Image size 2048x1536.
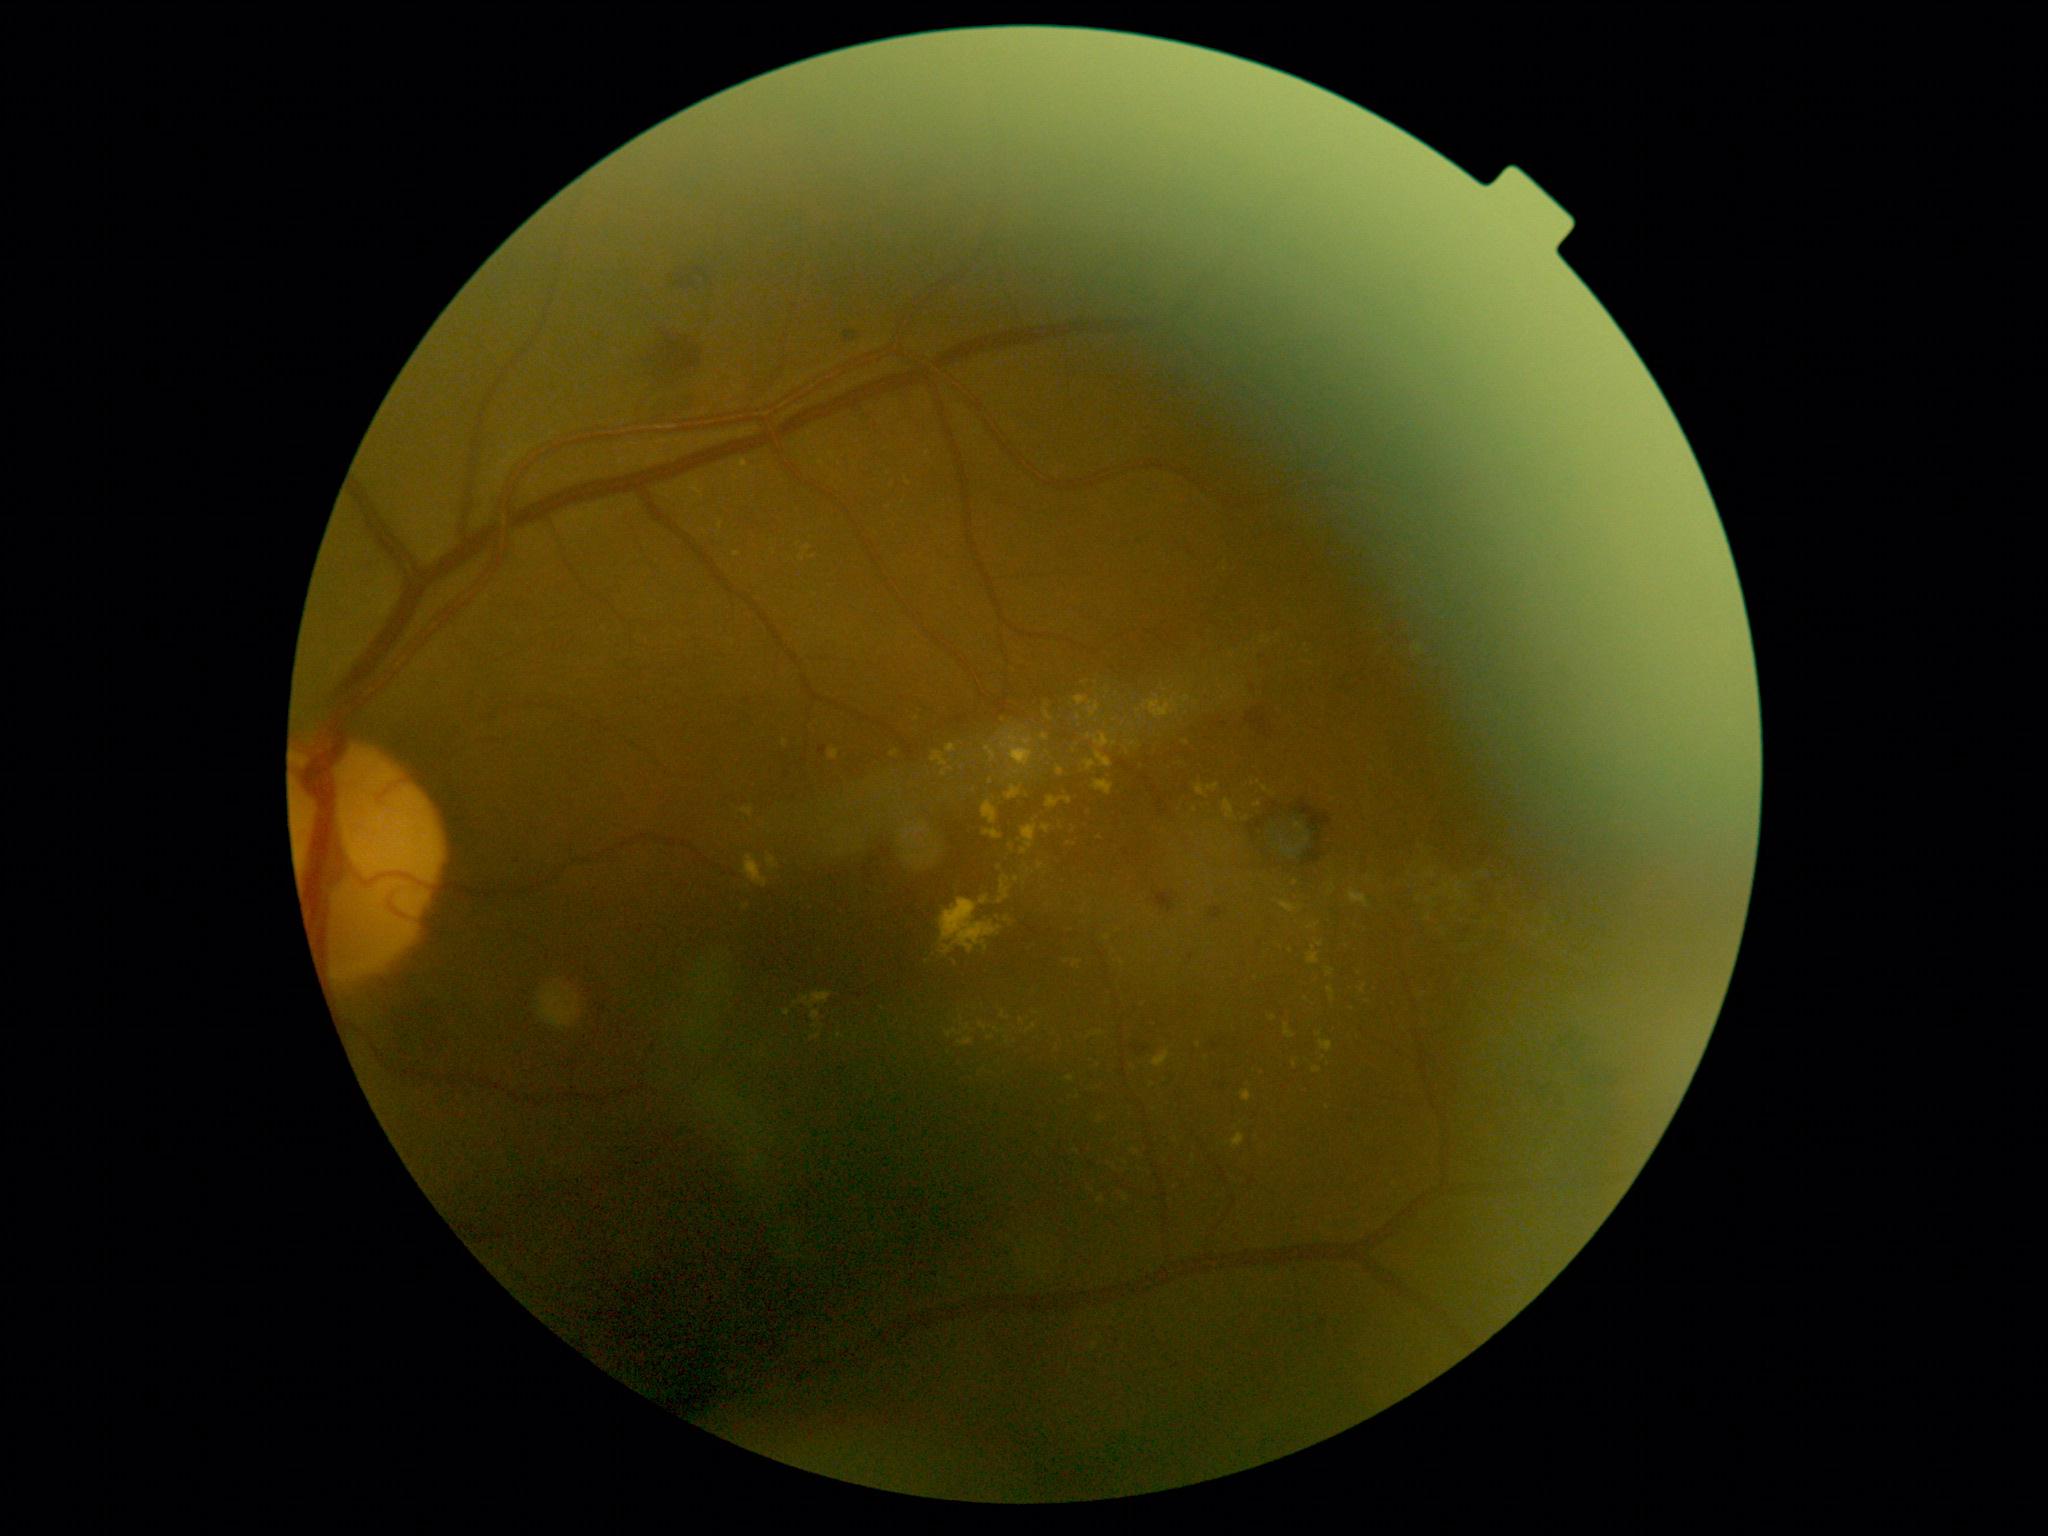 {"partial":true,"dr_grade":2,"dr_grade_name":"moderate NPDR","lesions":{"ex":[[1309,924,1319,930],[1153,1050,1170,1068],[980,897,990,906],[1307,953,1320,965],[740,459,748,468],[983,830,1003,840],[1254,803,1262,809],[1328,987,1335,1002],[1074,697,1102,719]],"ex_small_centers":[[1292,852],[1134,744],[1299,848],[1017,773],[1296,884],[816,1027],[1194,1159],[1061,827]]}}